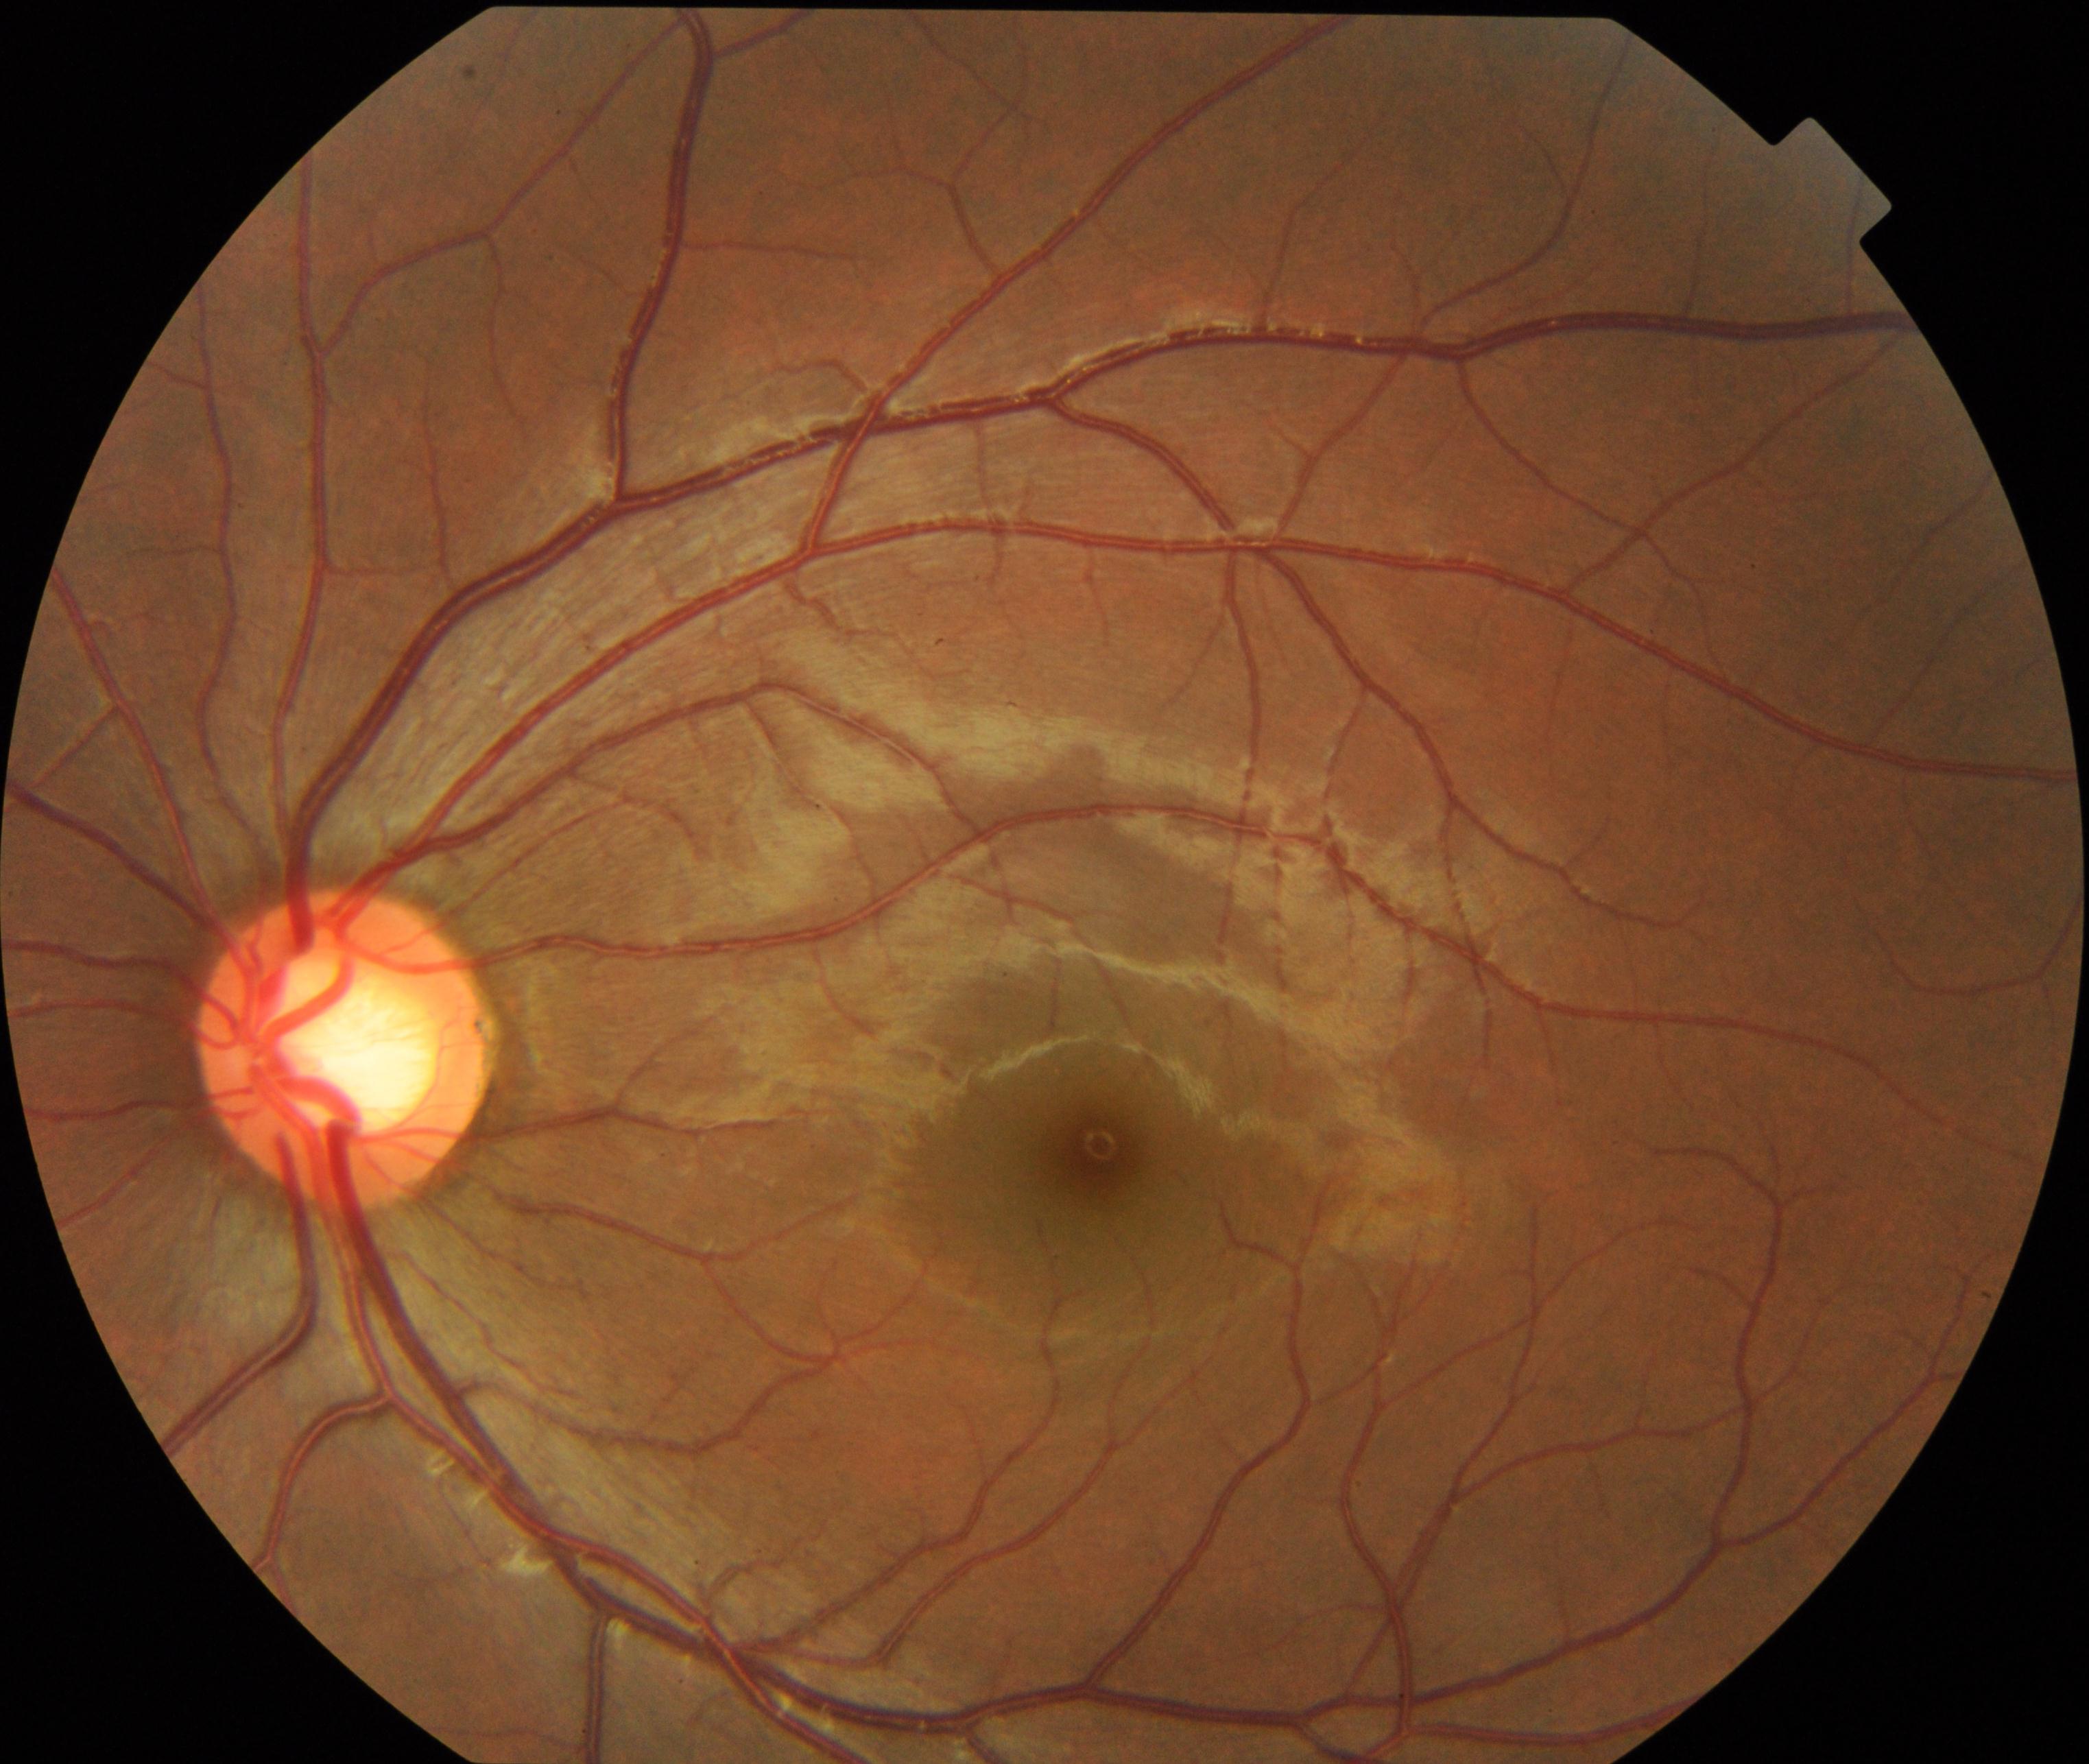
Impression: large optic cup.